45-degree field of view. 2212 by 1659 pixels. Color fundus image — 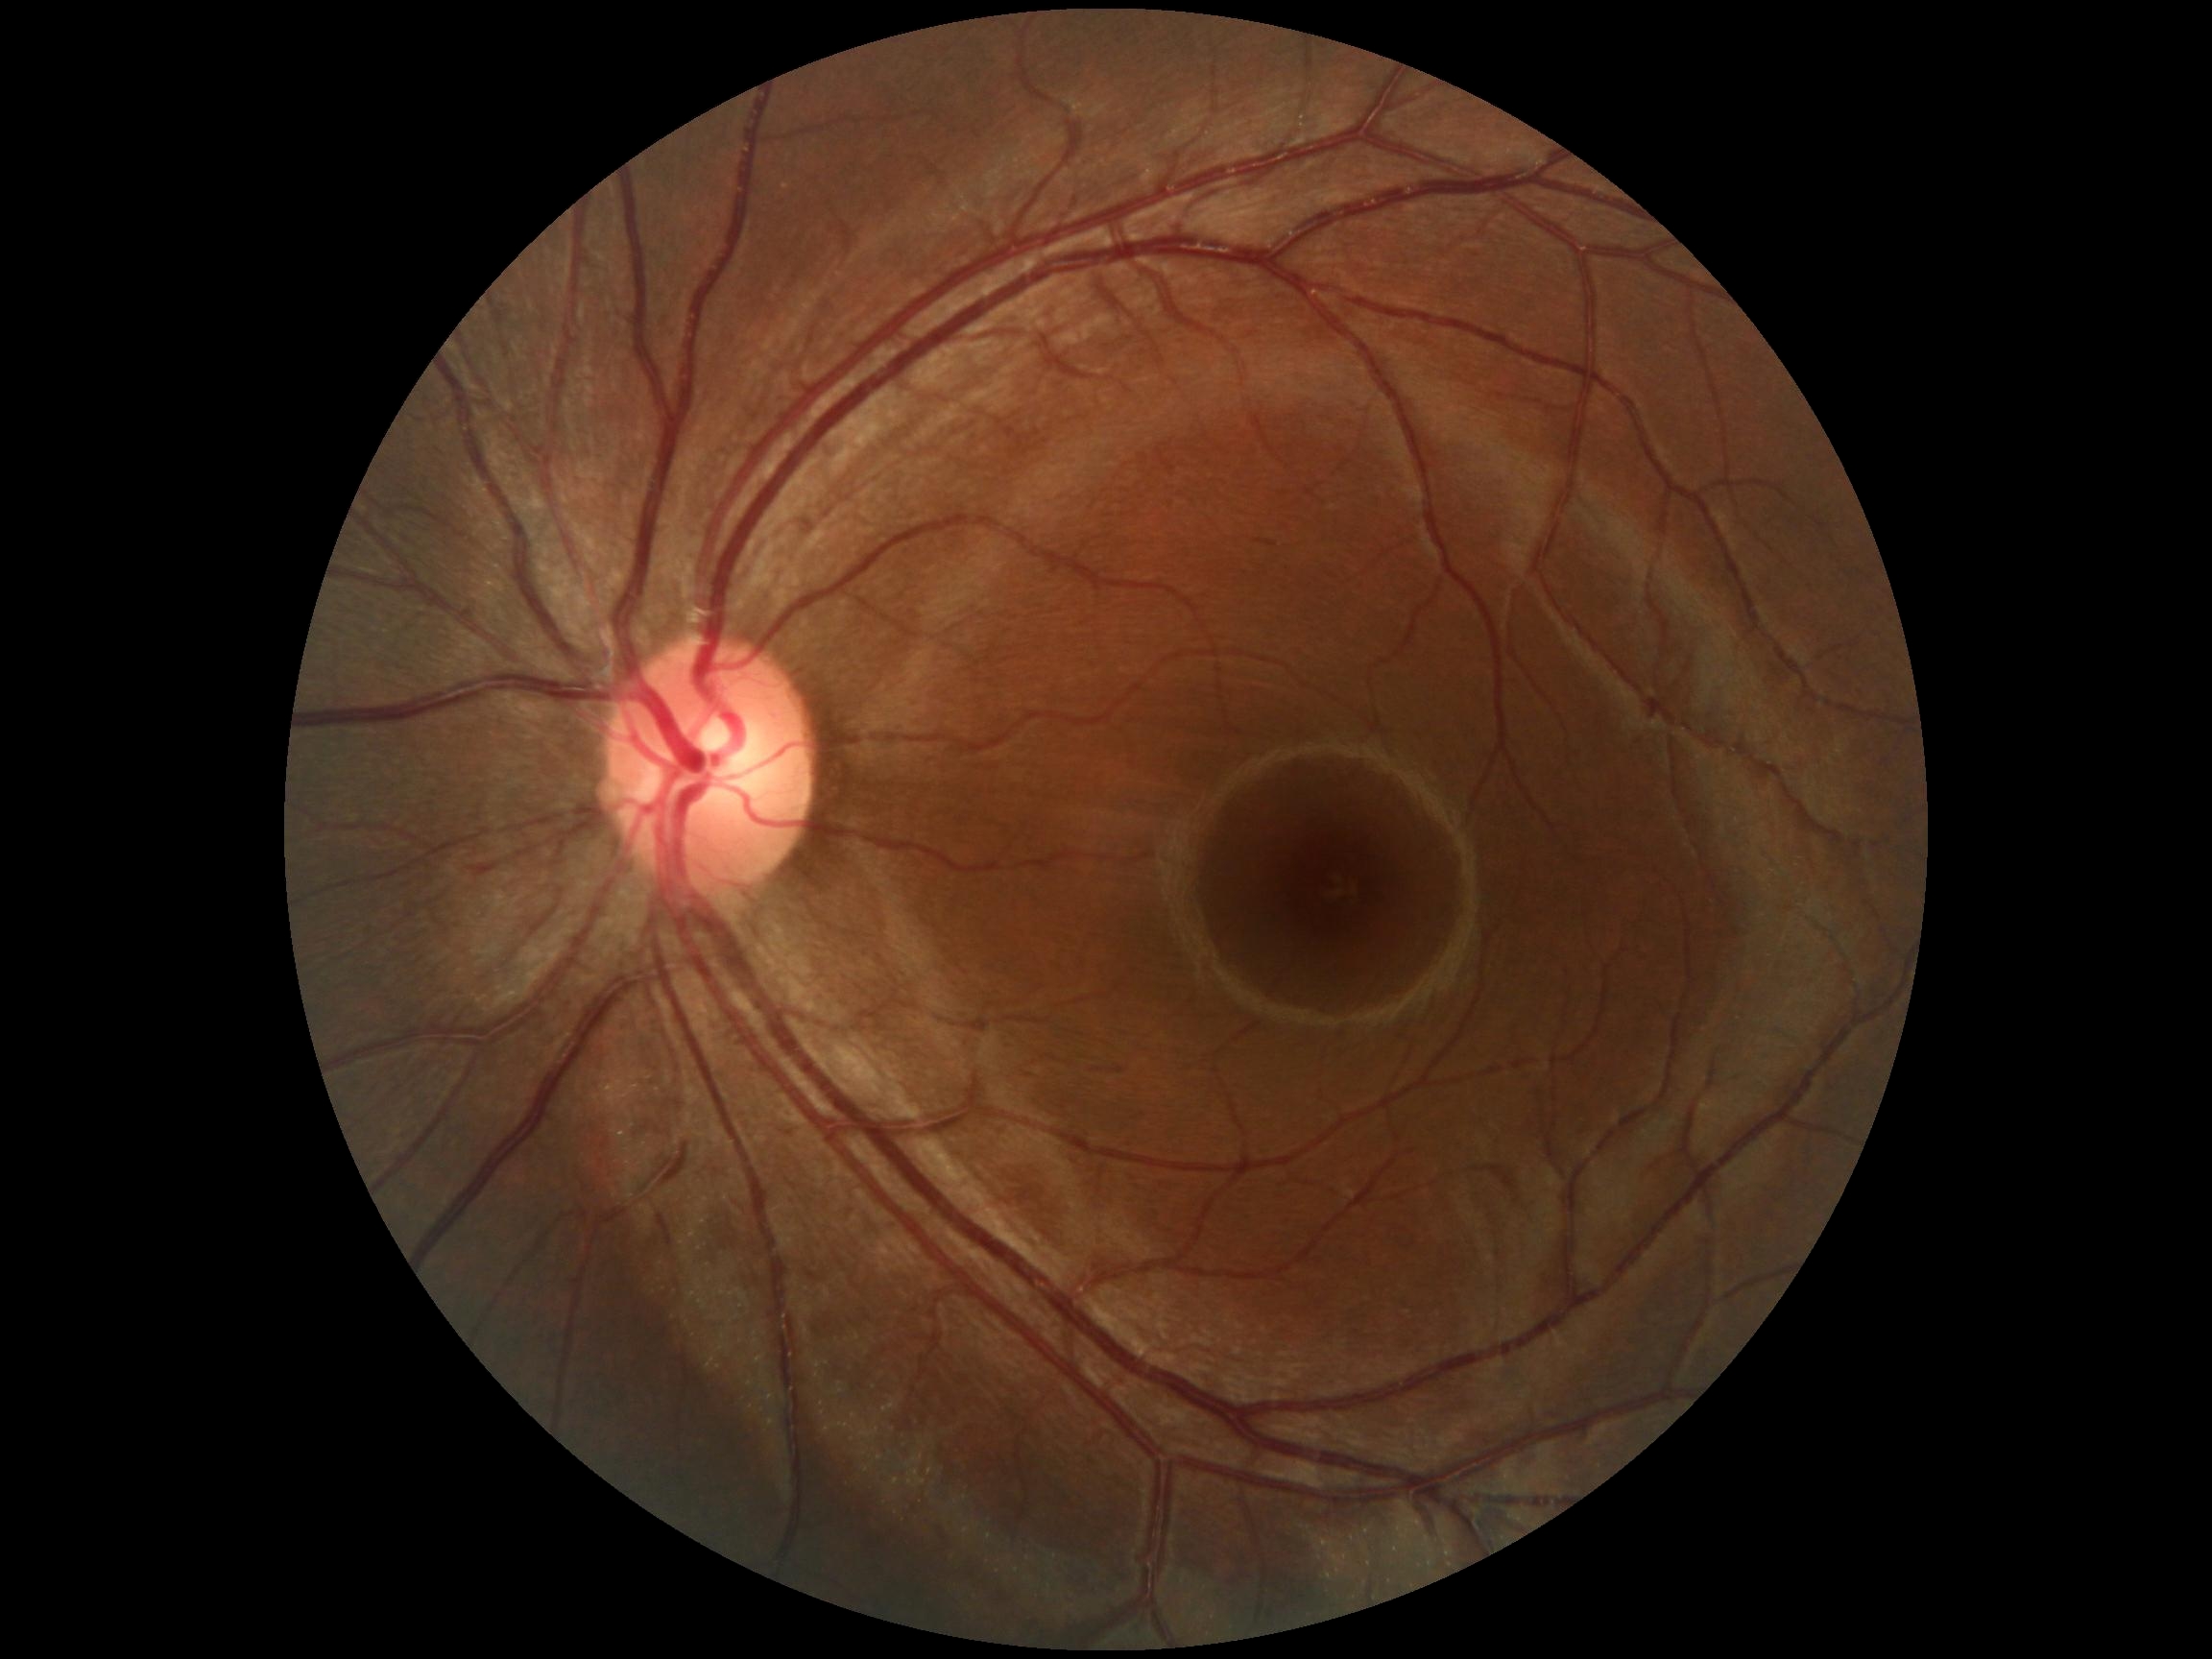

Retinopathy grade is 0 (no apparent retinopathy).